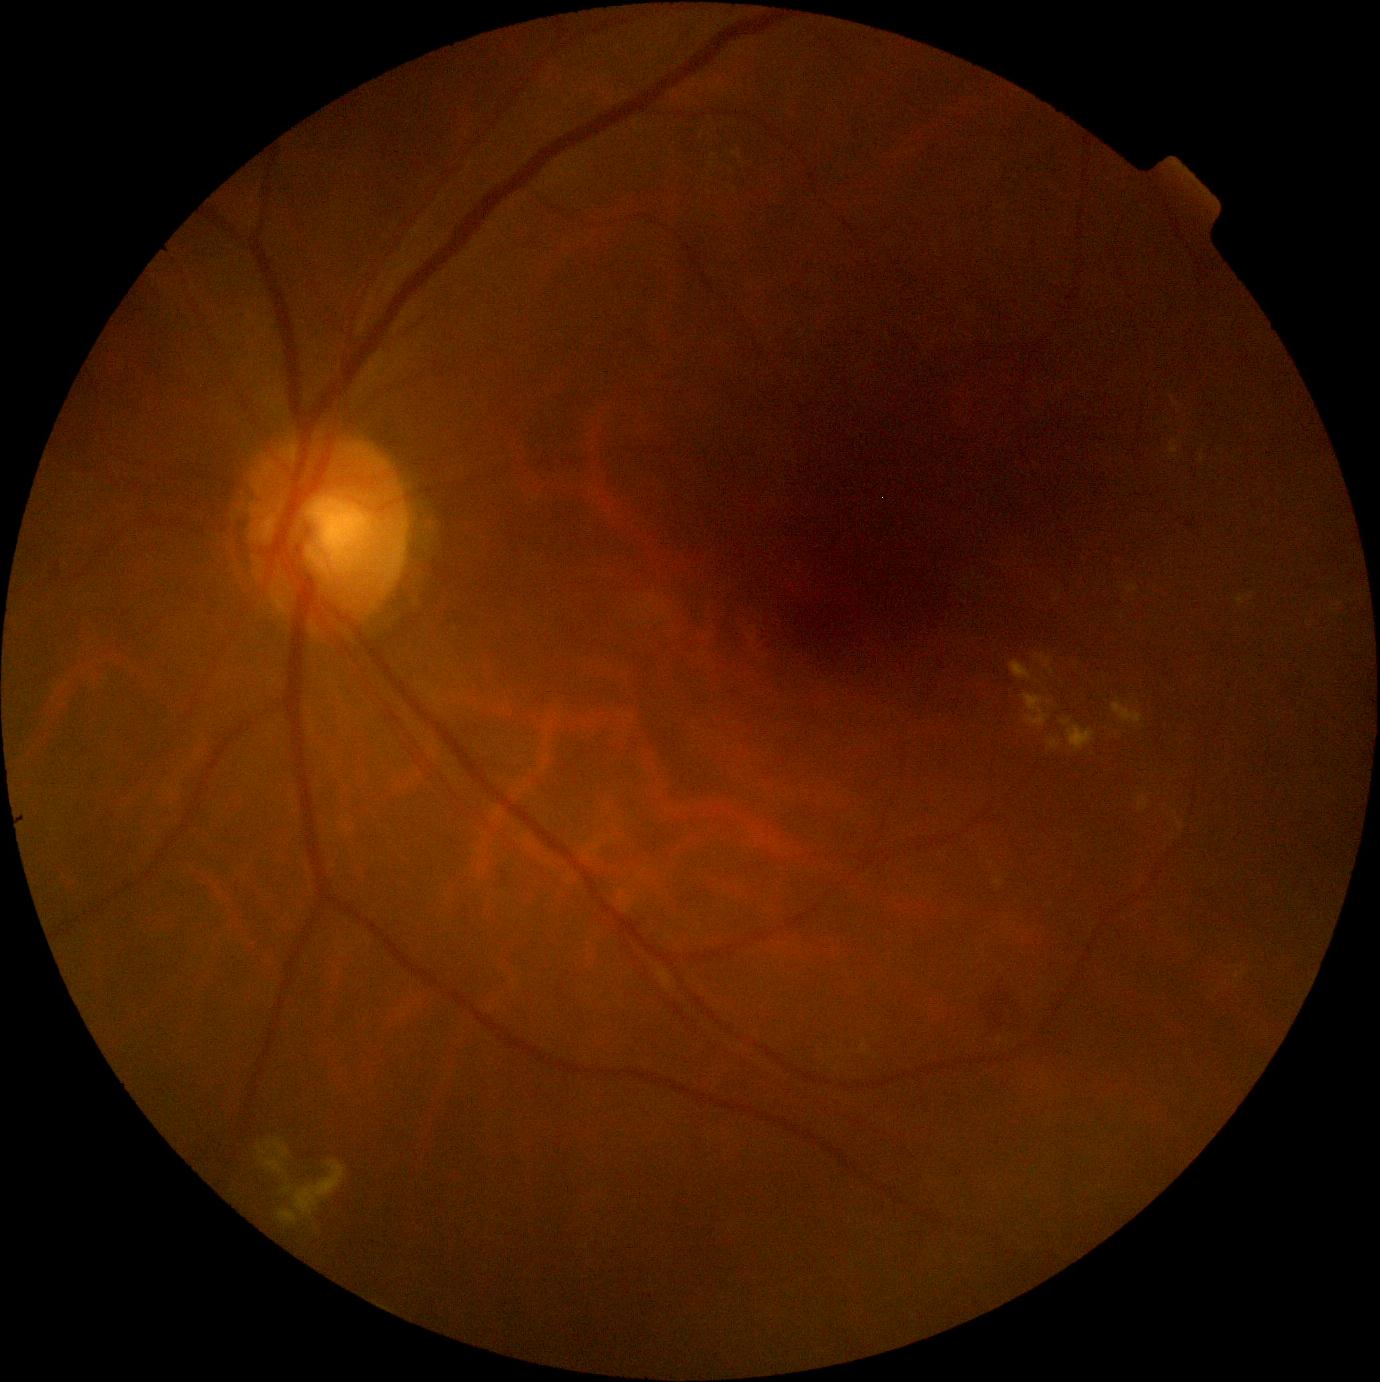
Diabetic retinopathy: moderate NPDR (grade 2).